DR severity per modified Davis staging: 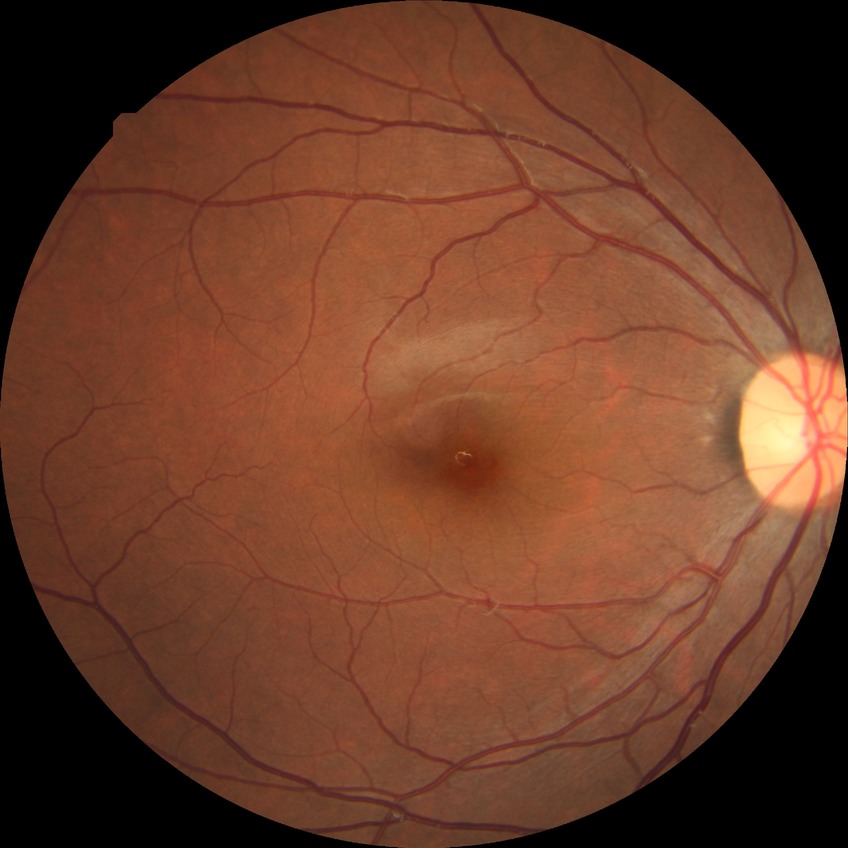 Diabetic retinopathy severity: no diabetic retinopathy.